Remidio Fundus on Phone (FOP) camera:
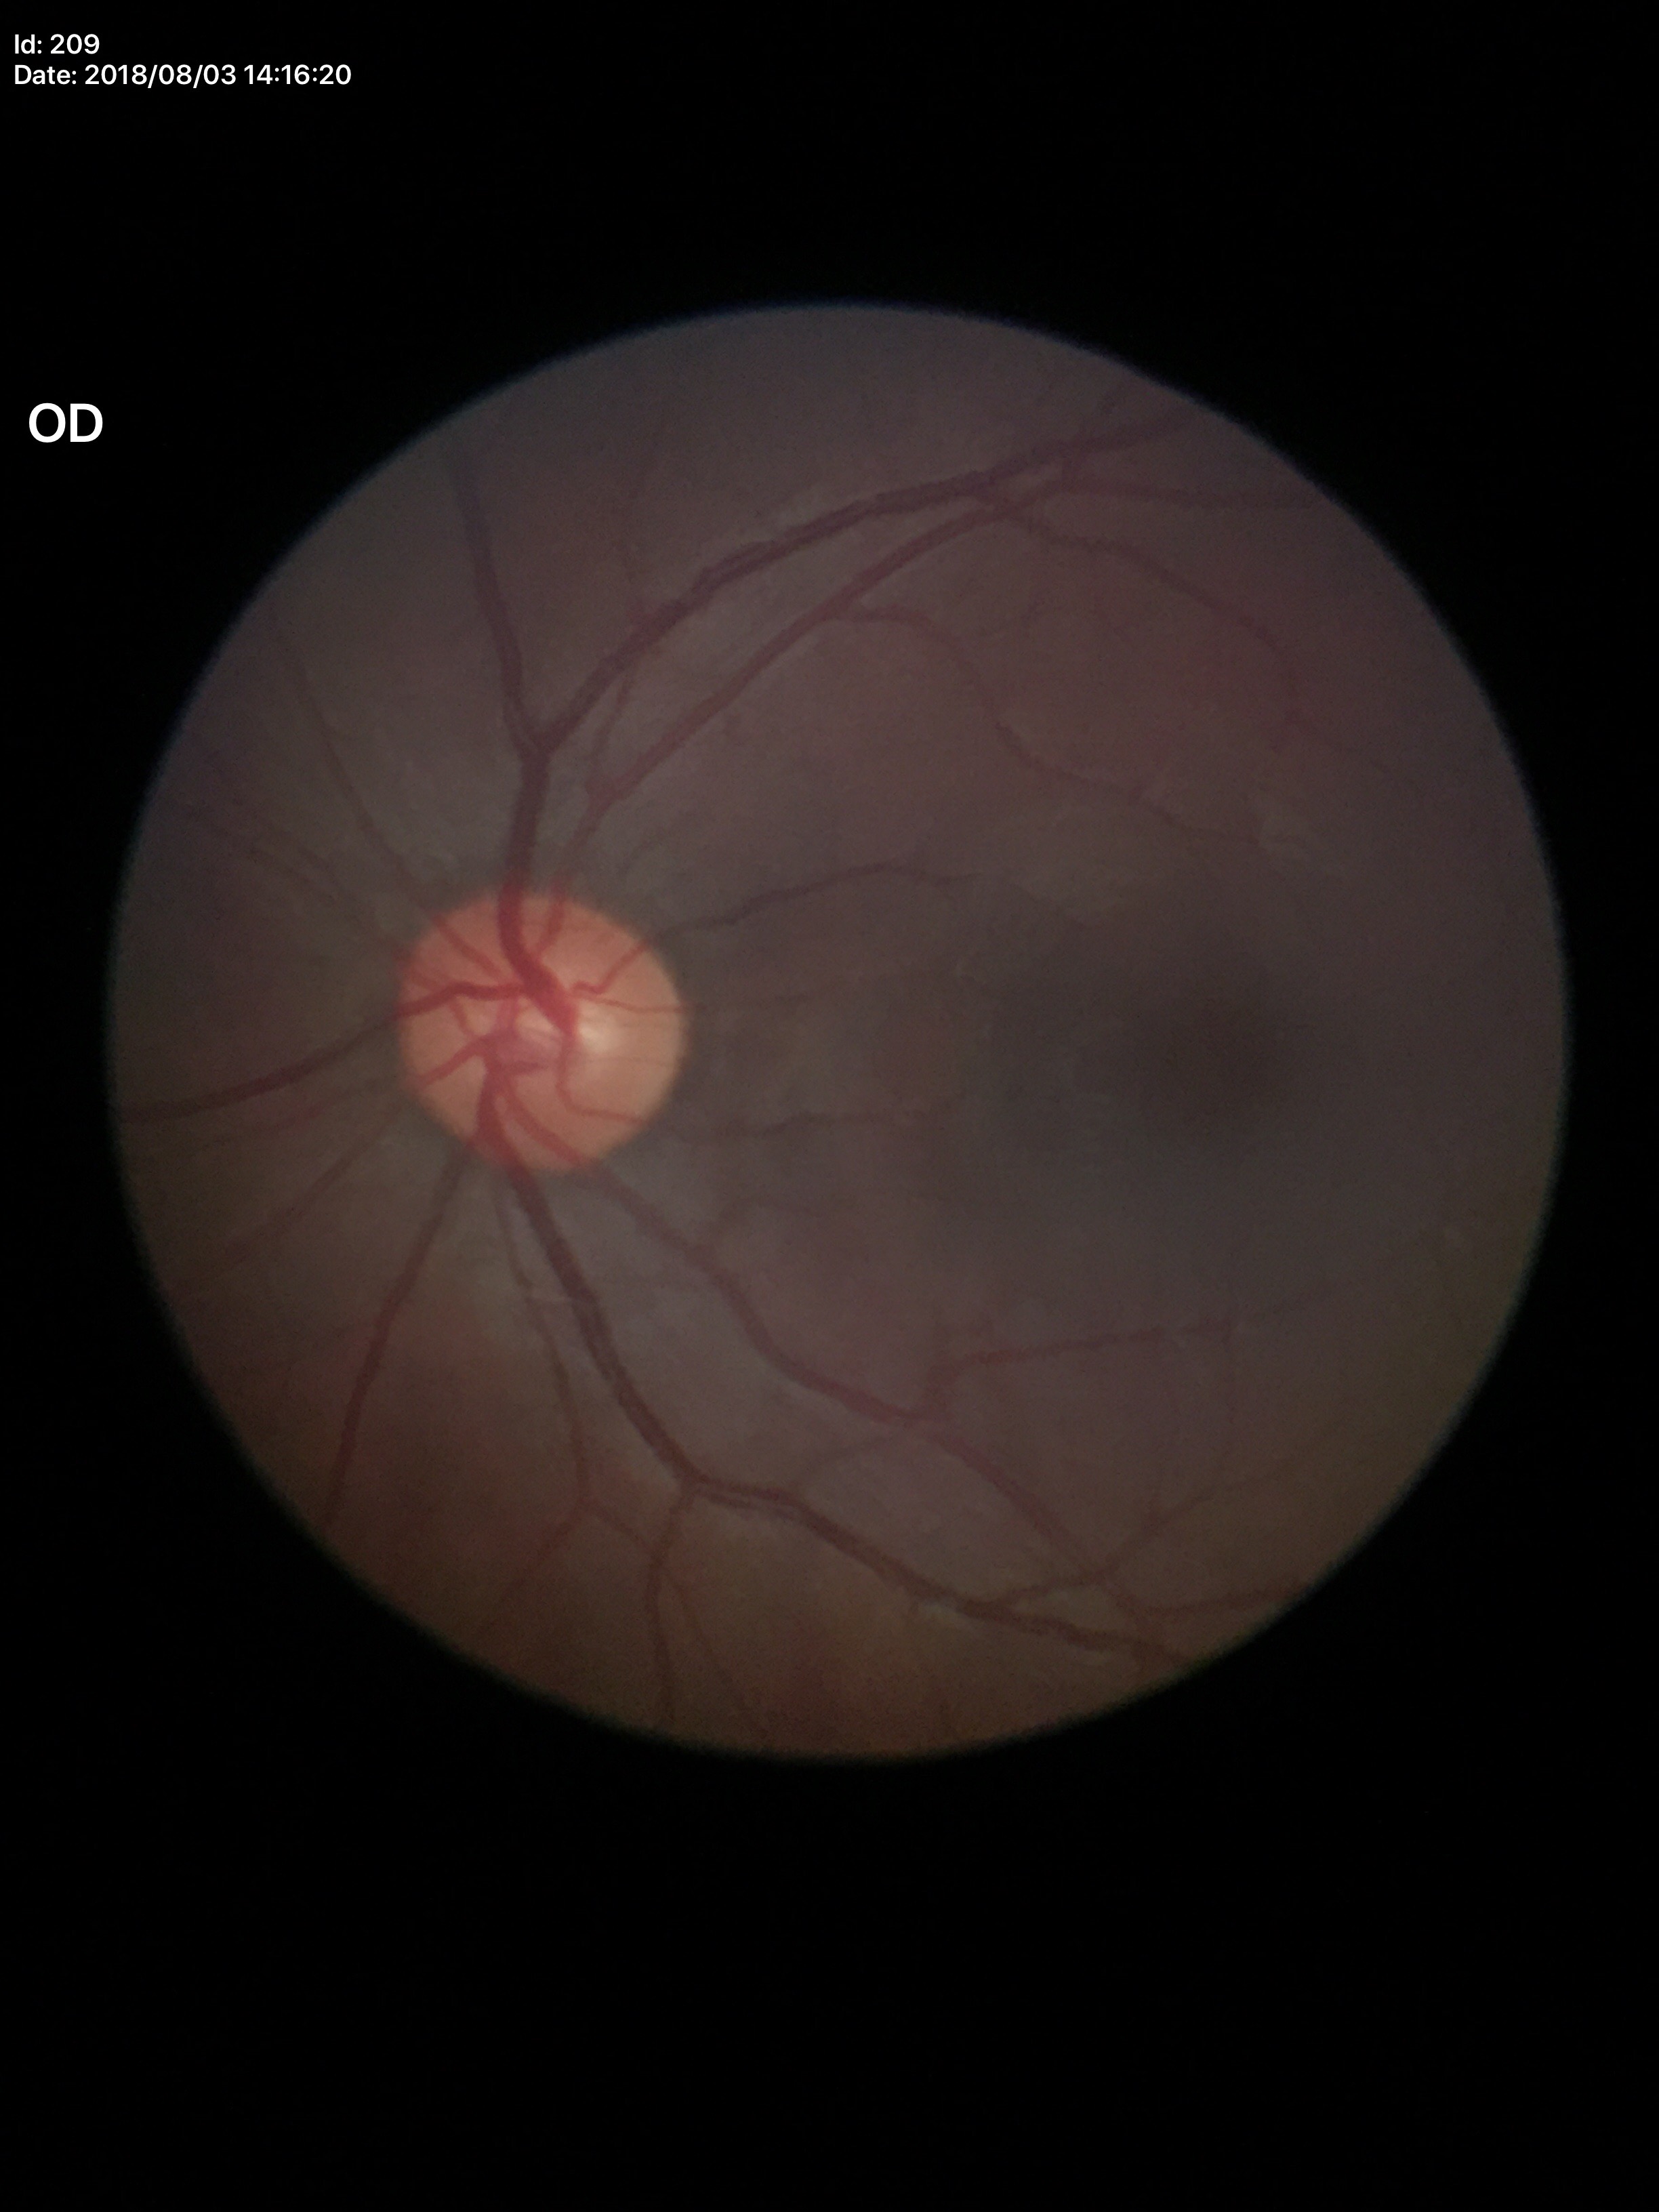

Q: What is the glaucoma assessment?
A: negative (all 5 graders called normal)
Q: Horizontal CDR?
A: 0.50
Q: What is the vertical cup-to-disc ratio?
A: 0.43